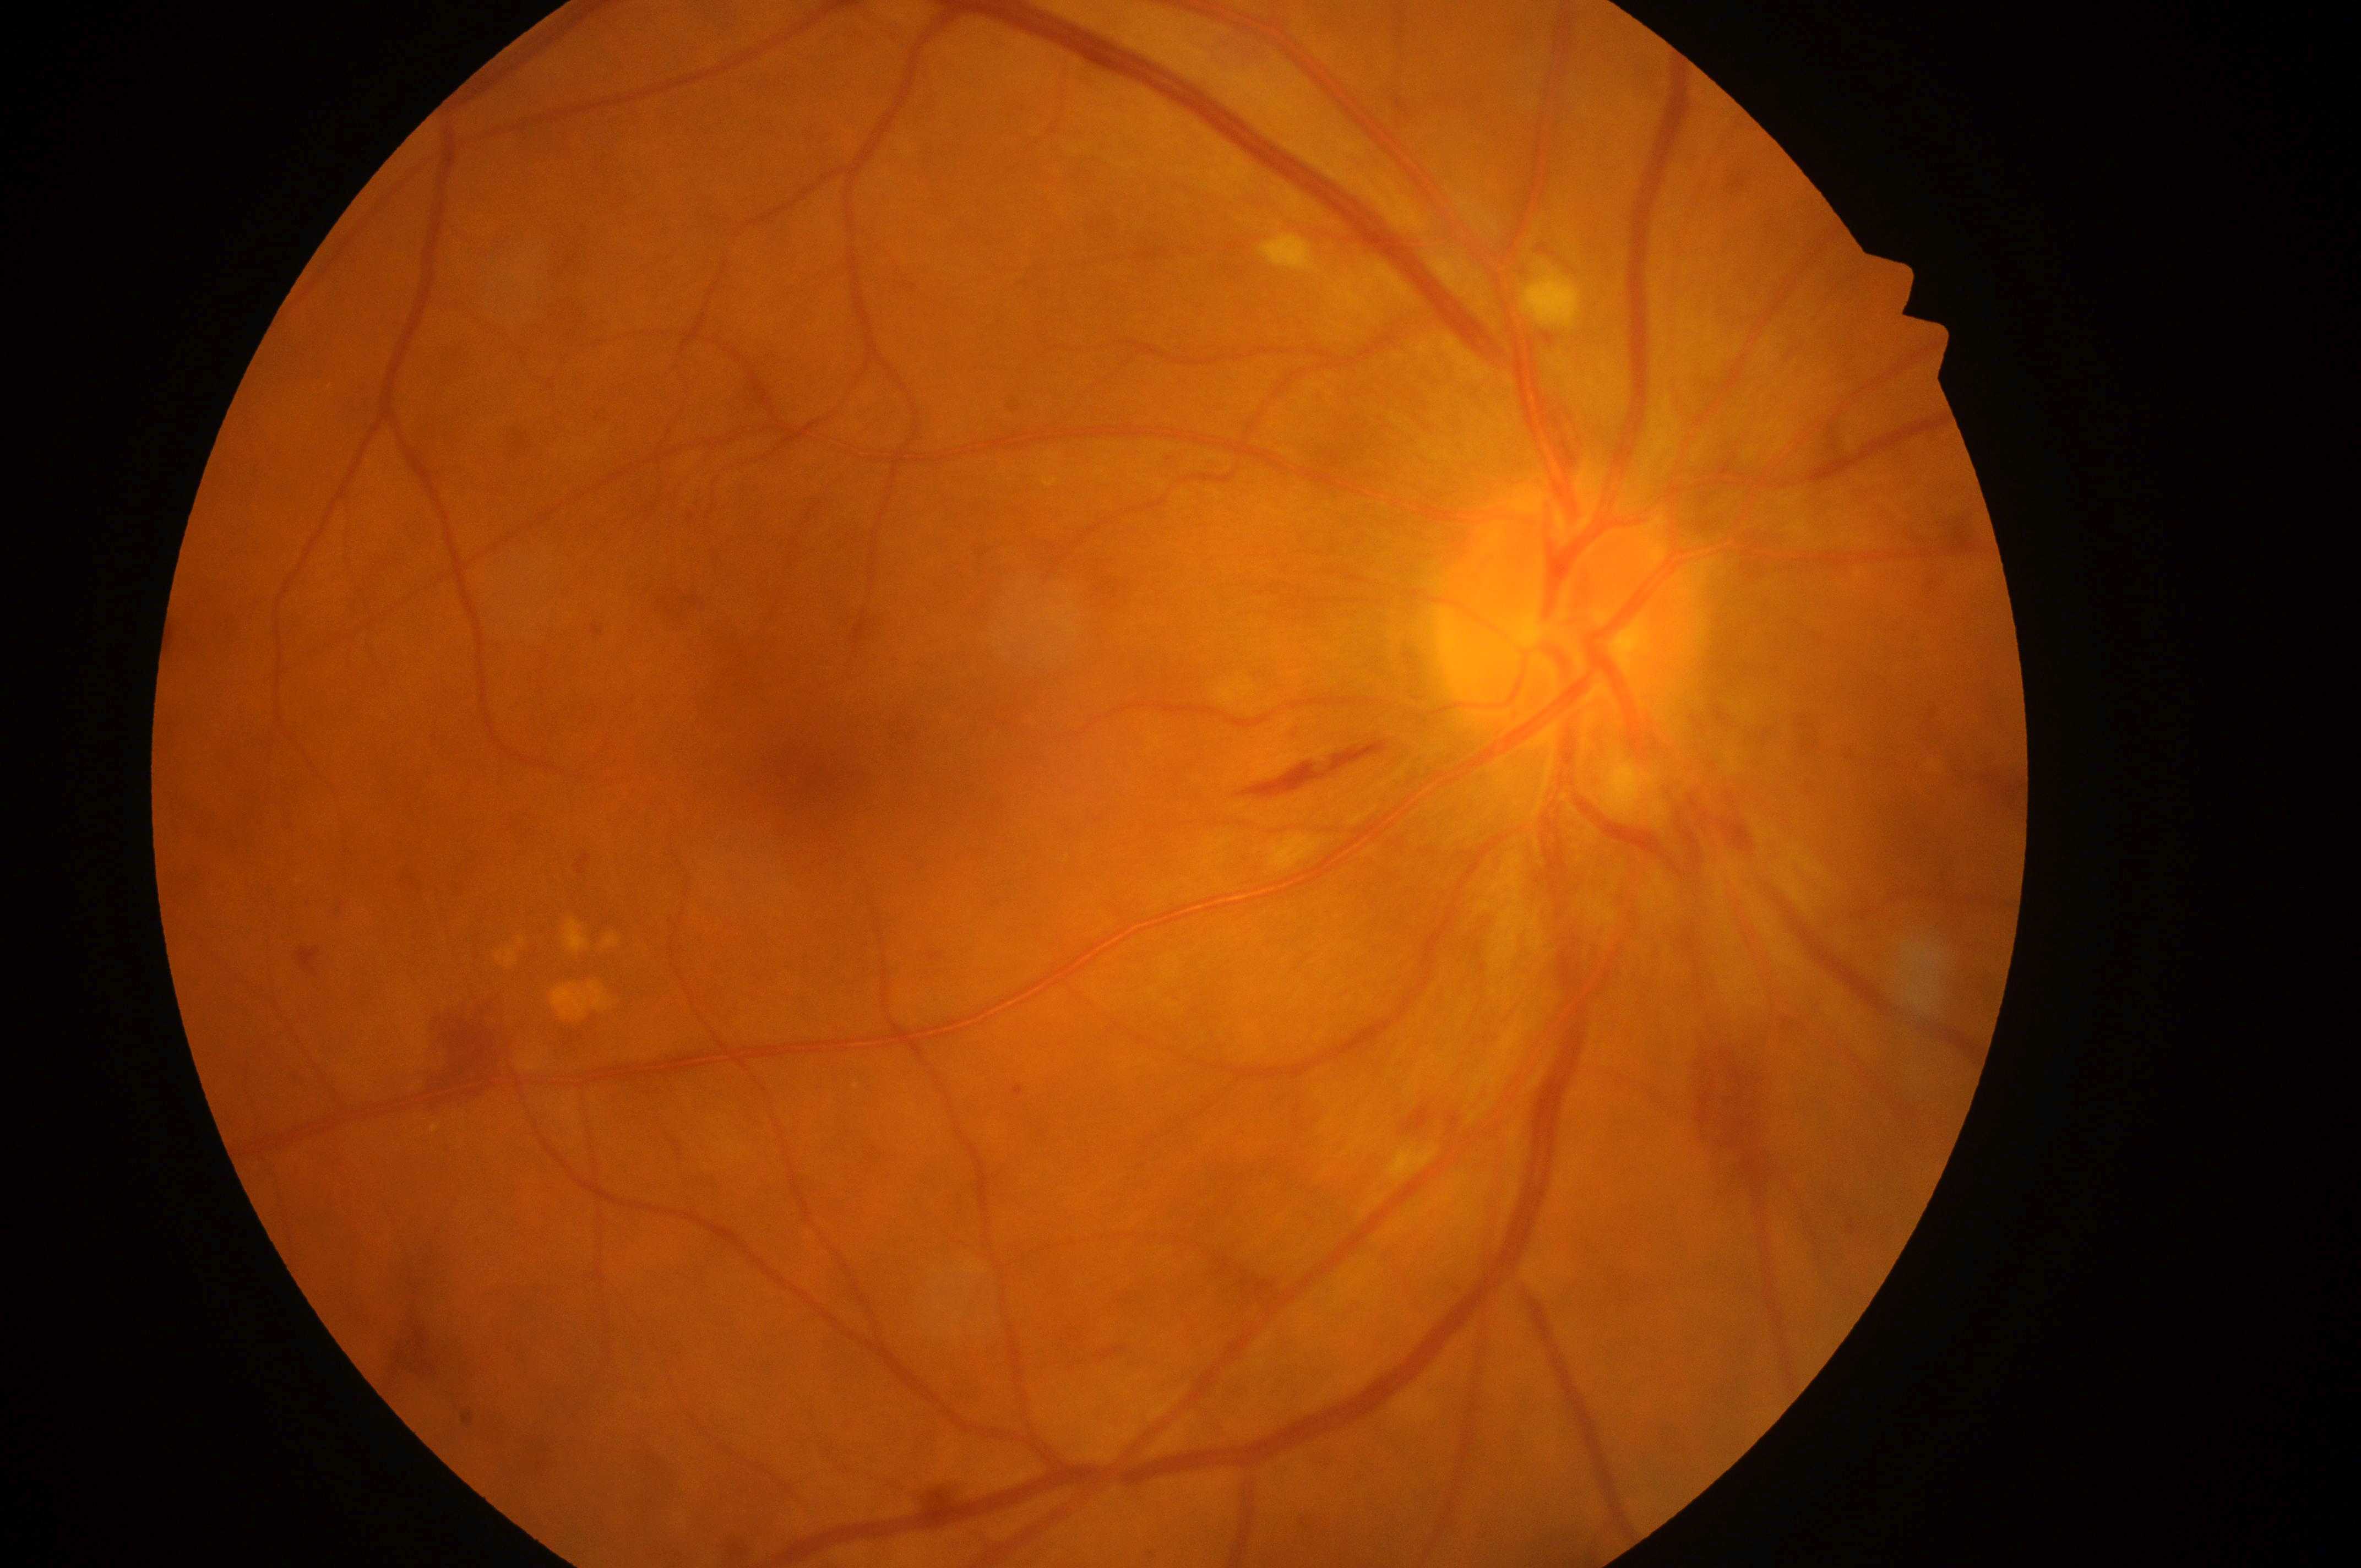 DME risk is grade 1 (low risk). The image shows the right eye. The fovea centralis is at (x: 827, y: 763). DR severity is grade 4 (PDR). Optic nerve head: (x: 1568, y: 627).